45-degree field of view.
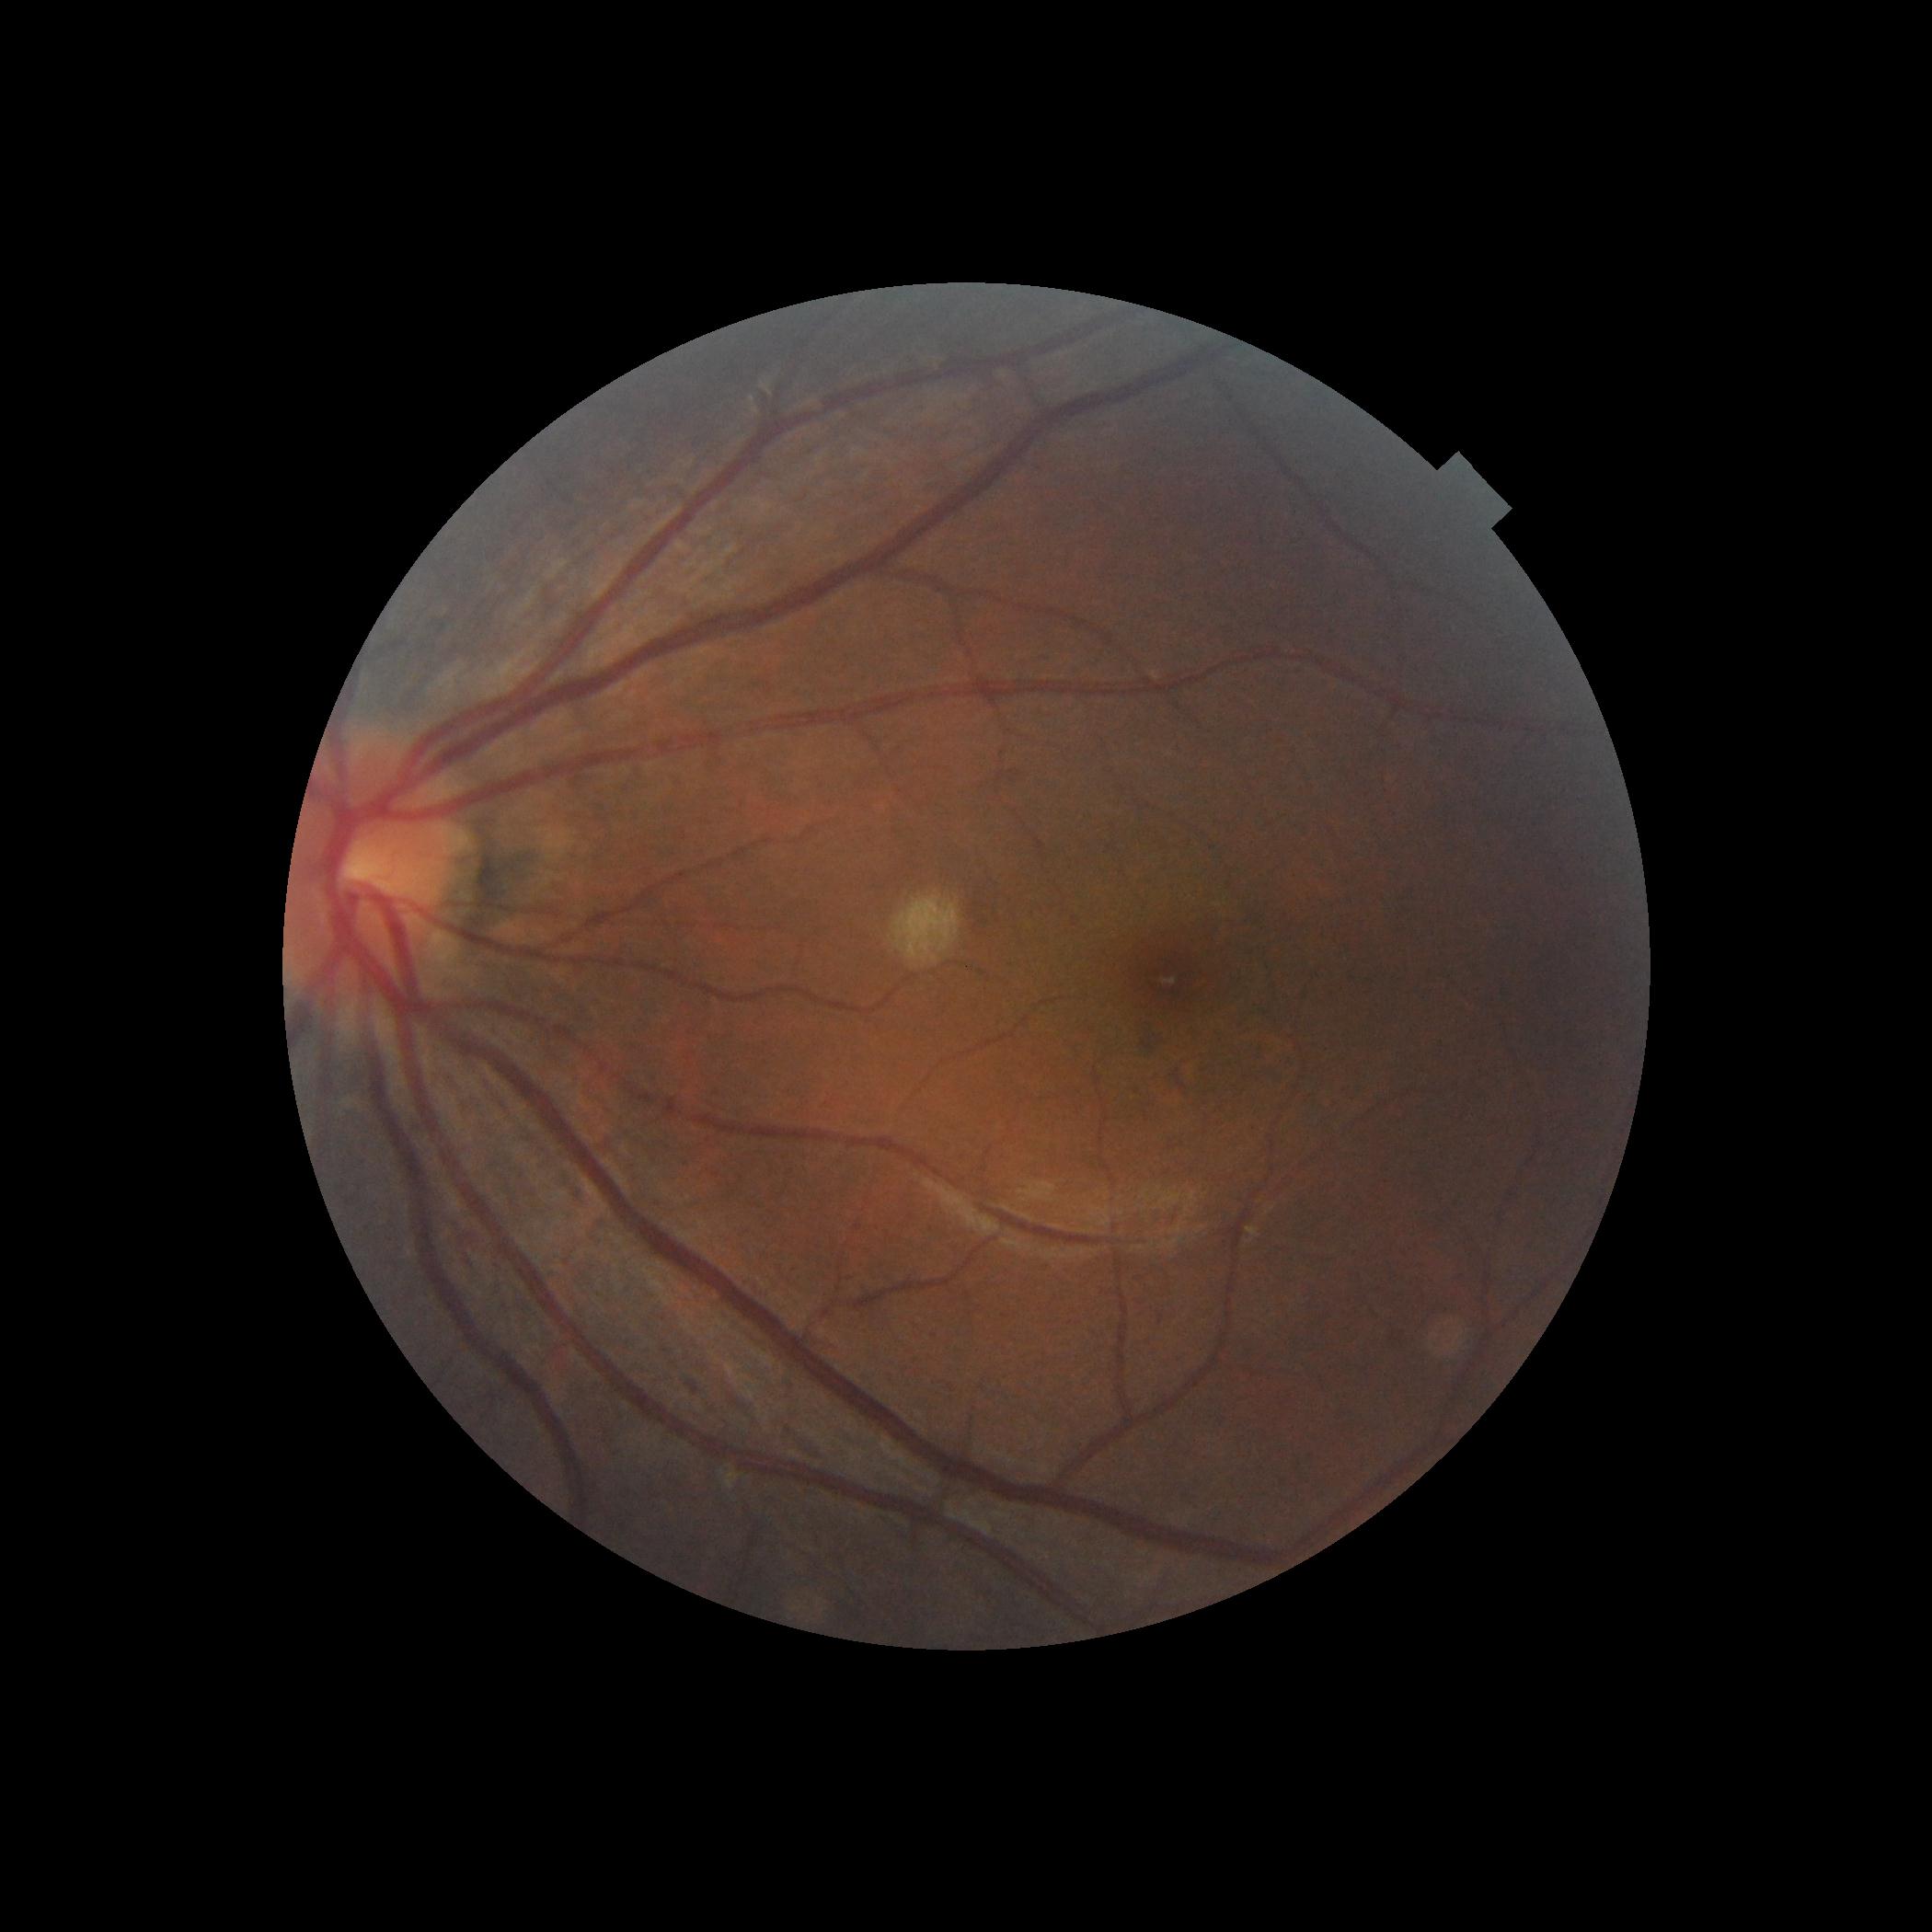 diabetic retinopathy severity: grade 0.